Mydriatic acquisition. Acquired with a Topcon TRC. Fundus image cropped to the optic disc — 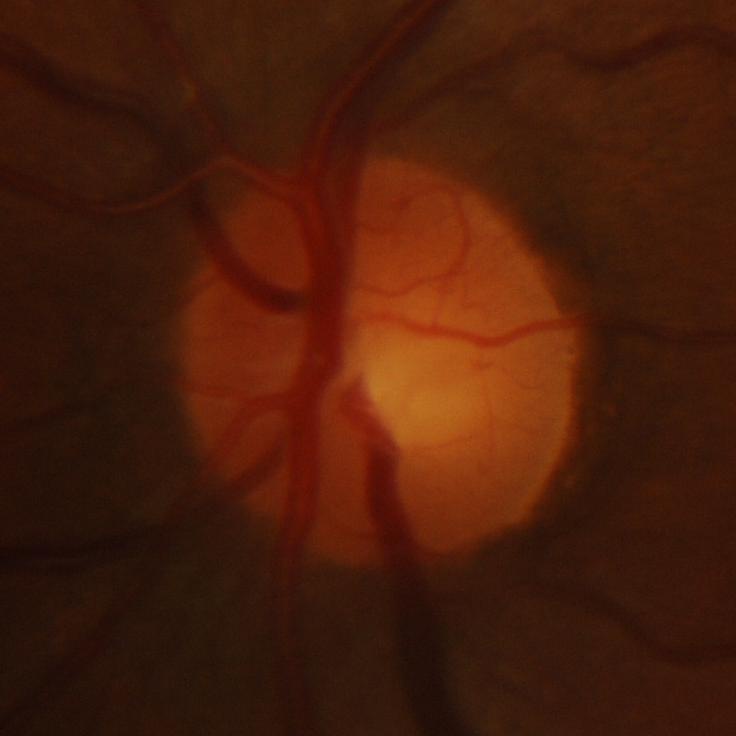

Glaucomatous changes are present. Glaucoma assessment = glaucomatous changes.